Without pupil dilation · 848x848 · color fundus image · 45° FOV — 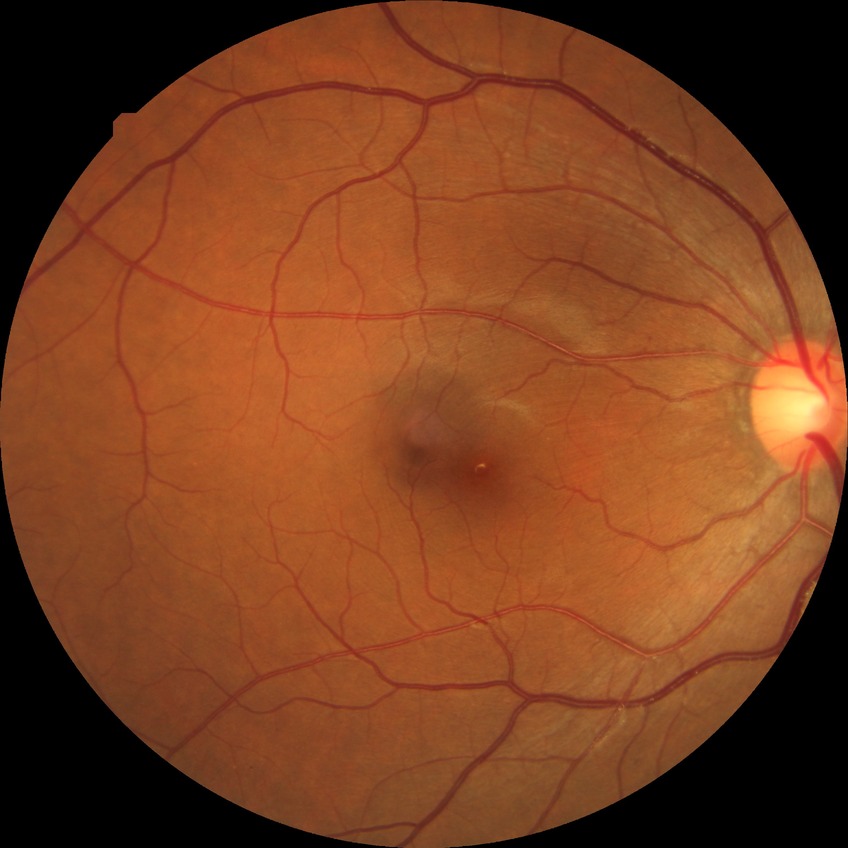
Annotations:
- DR grade — NDR
- DR impression — no DR findings